Wide-field fundus photograph from neonatal ROP screening; 640x480 — 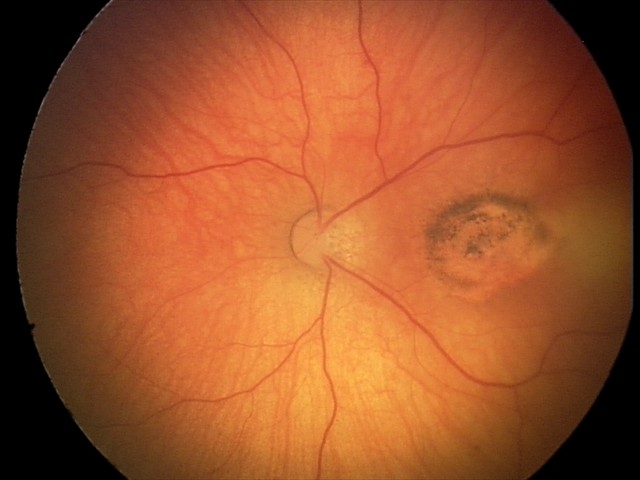
Finding: toxoplasmosis chorioretinitis.